Acquired on the Phoenix ICON. Image size 1240x1240. Pediatric retinal photograph (wide-field): 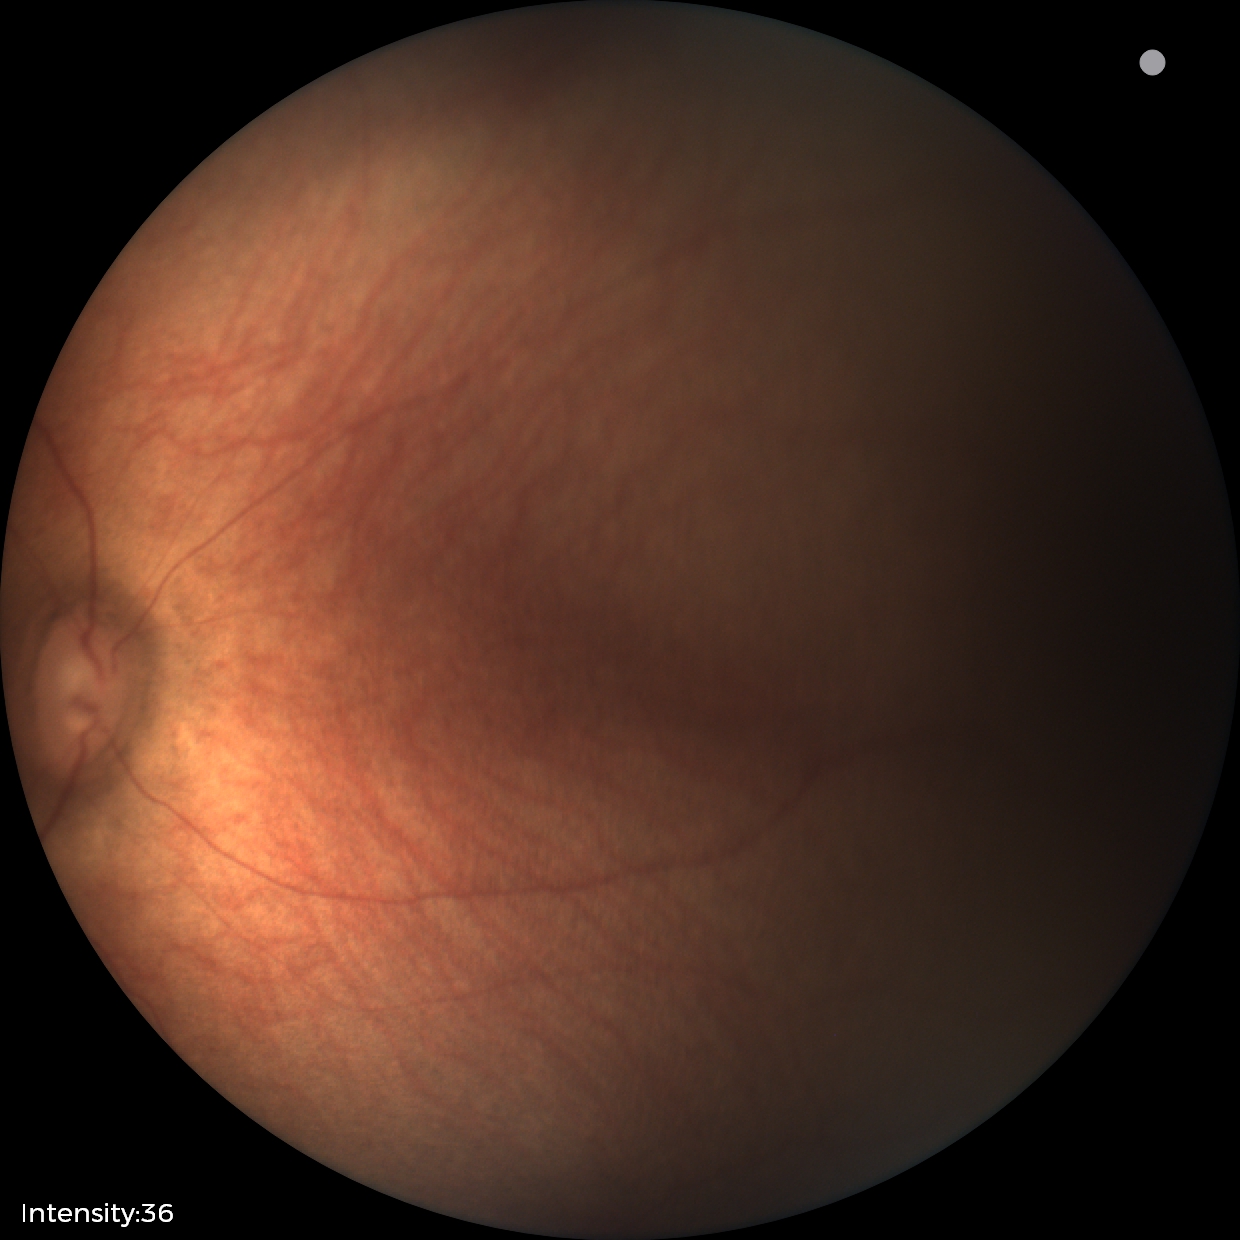

Screening diagnosis = normal retinal appearance.